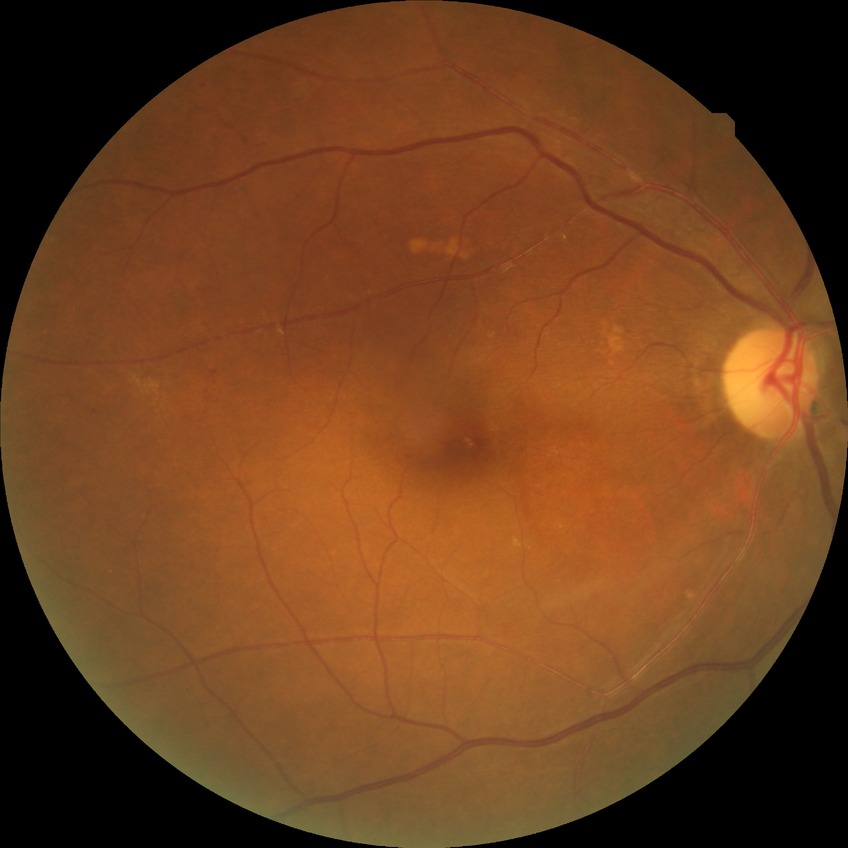

{
  "davis_grade": "simple diabetic retinopathy"
}